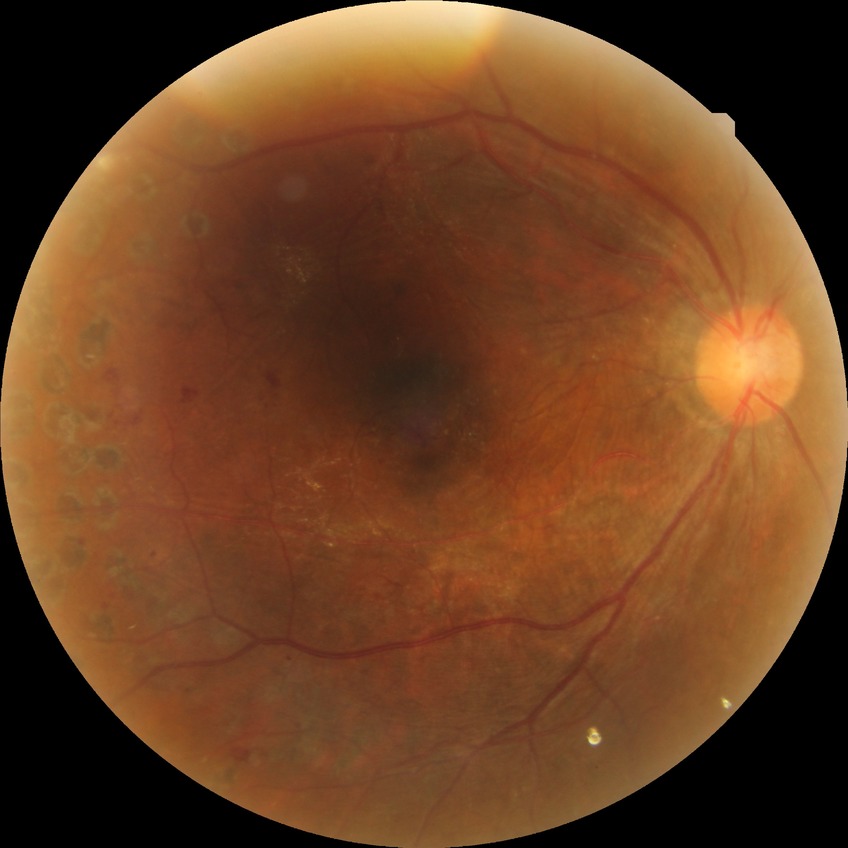
Assessment:
- DR severity — PDR